Color fundus photograph; 2352x1568px
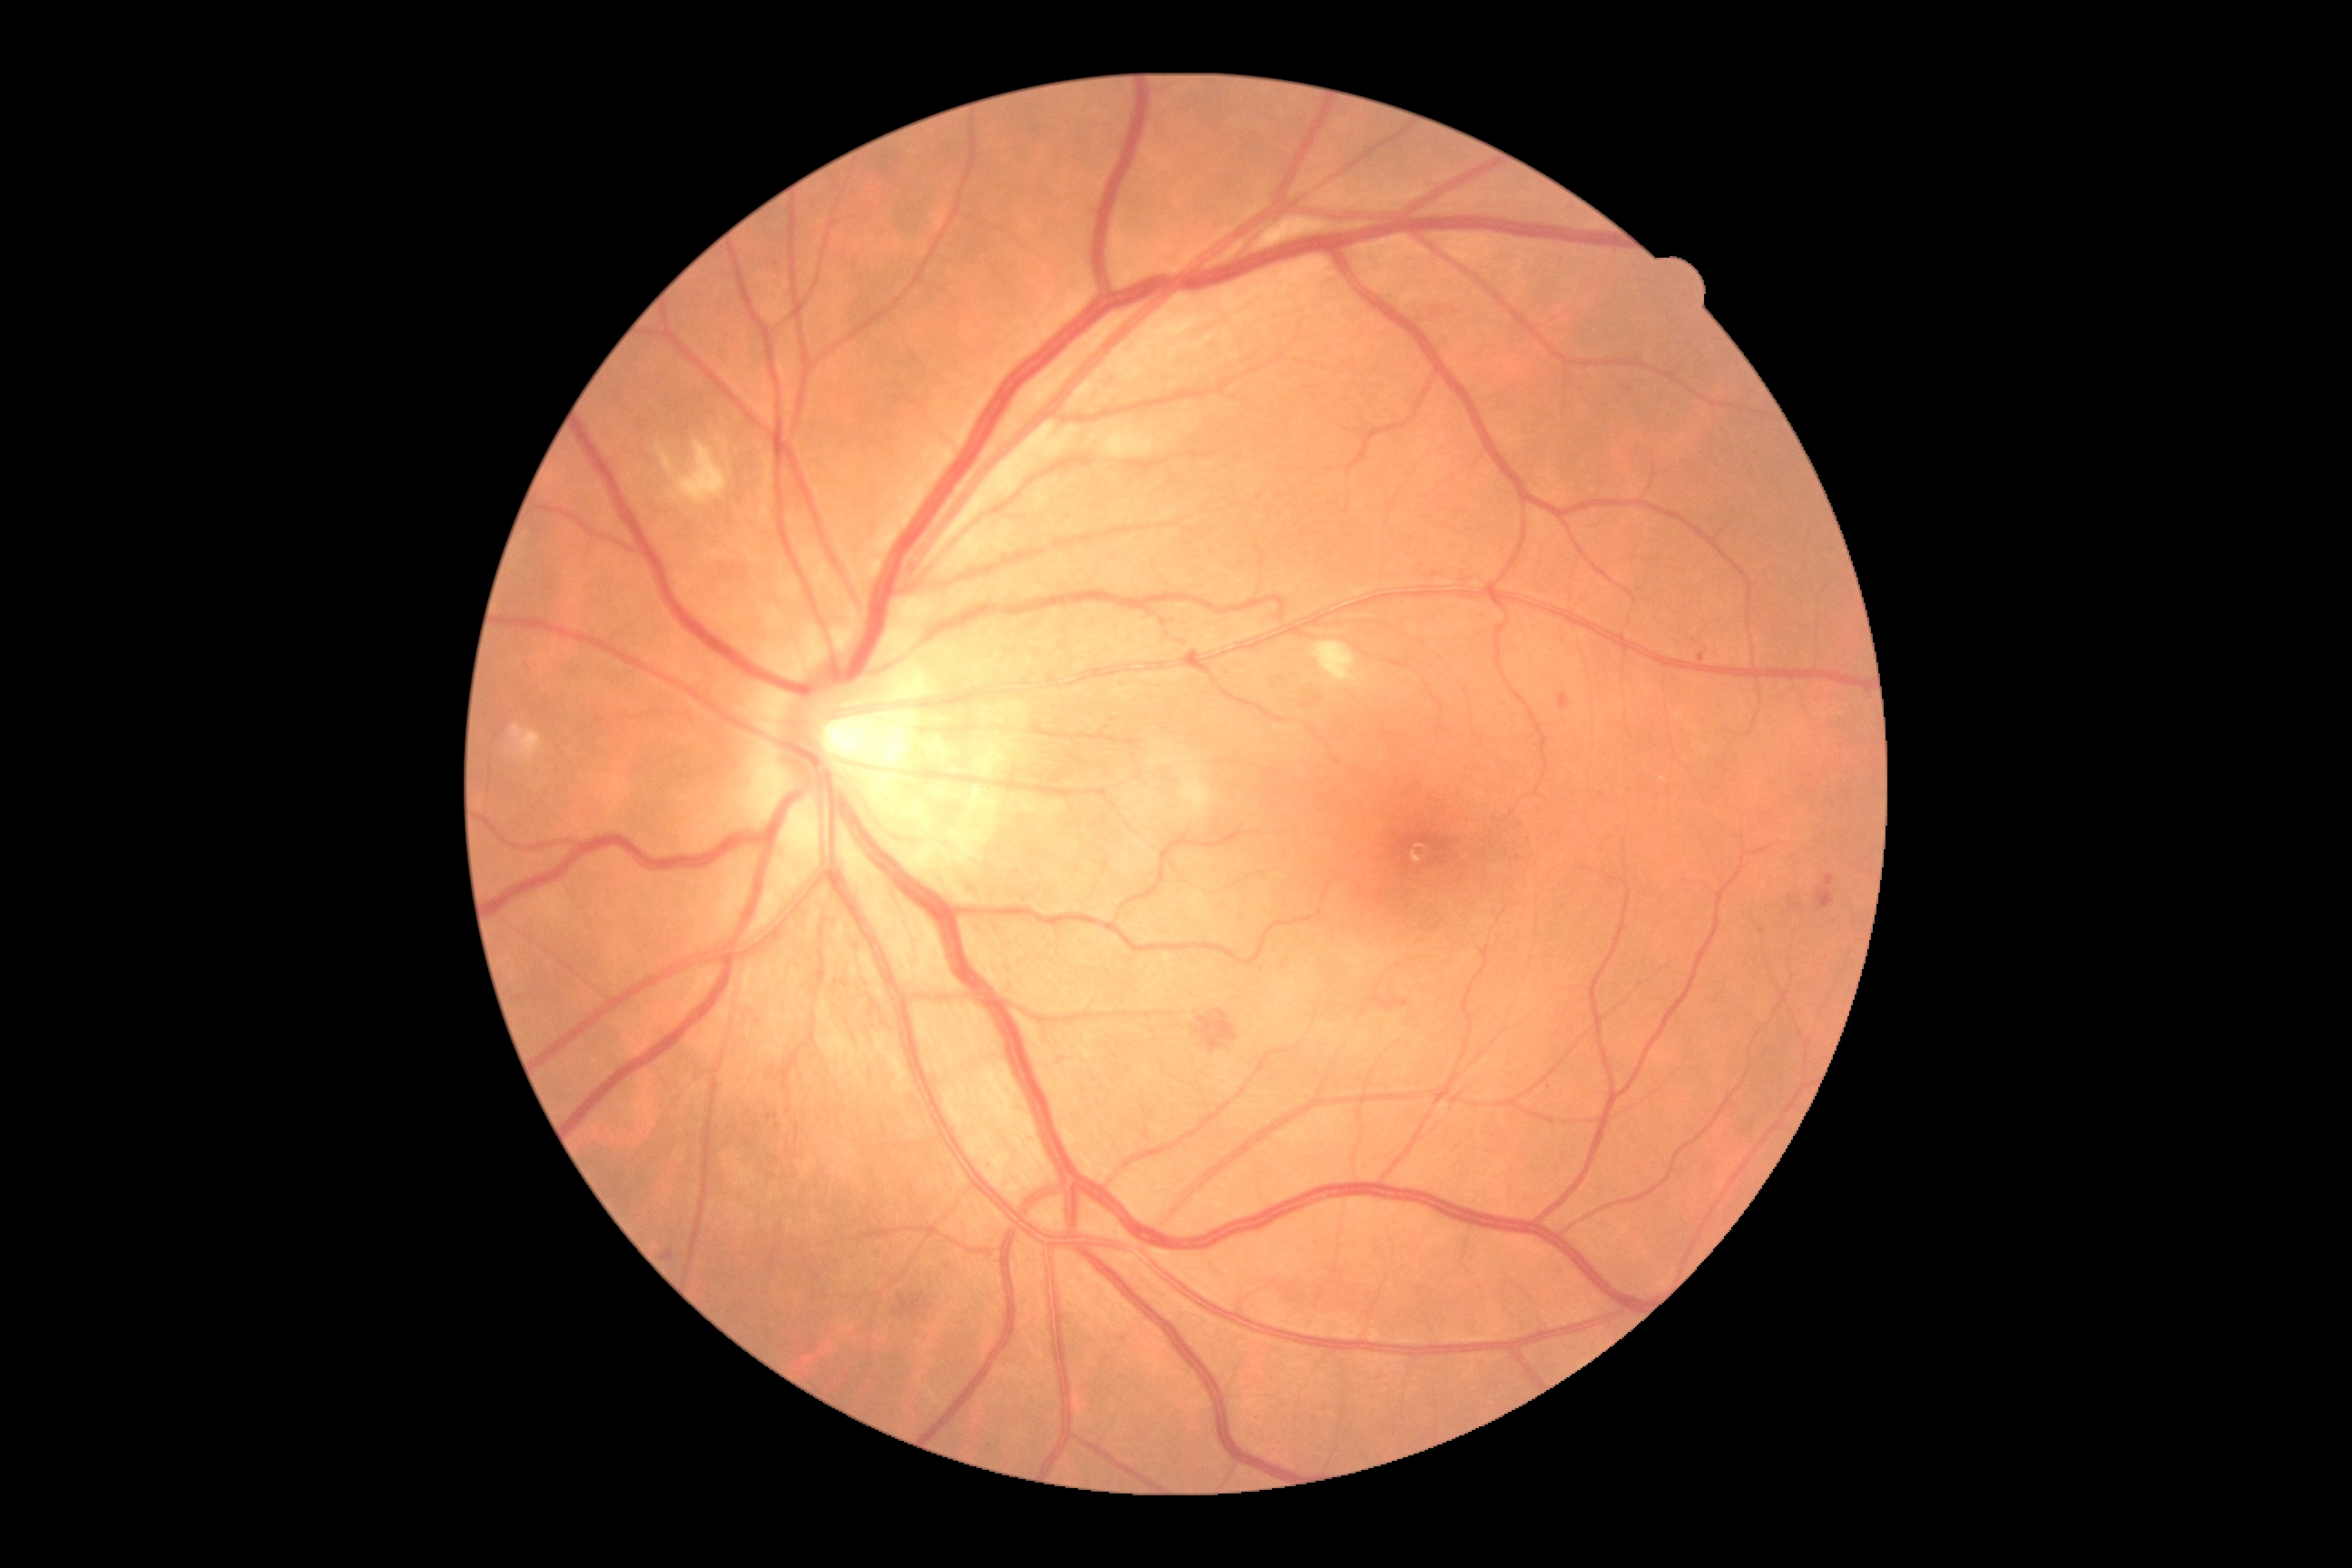 <lesions partial="true">
  <dr_grade>2</dr_grade>
  <he>[1195,1010,1239,1054], [1375,995,1398,1010], [1415,304,1462,322], [1306,694,1324,707], [1816,888,1834,908], [910,1313,919,1318], [897,1295,923,1313]</he>
  <se>[1179,767,1213,818], [671,442,729,504], [660,449,676,478], [1311,642,1366,687]</se>
  <se_small_centers>[x=660, y=448]</se_small_centers>
  <ex />
  <ma partial="true">[1558,692,1571,710], [663,1250,676,1262], [1400,999,1409,1008], [1825,874,1834,888], [1563,380,1573,391], [1698,652,1705,663]</ma>
  <ma_small_centers>[x=769, y=1116], [x=1104, y=821], [x=1630, y=392], [x=776, y=1116], [x=1019, y=1109]</ma_small_centers>
</lesions>